Macula at the center of the field; color fundus photograph
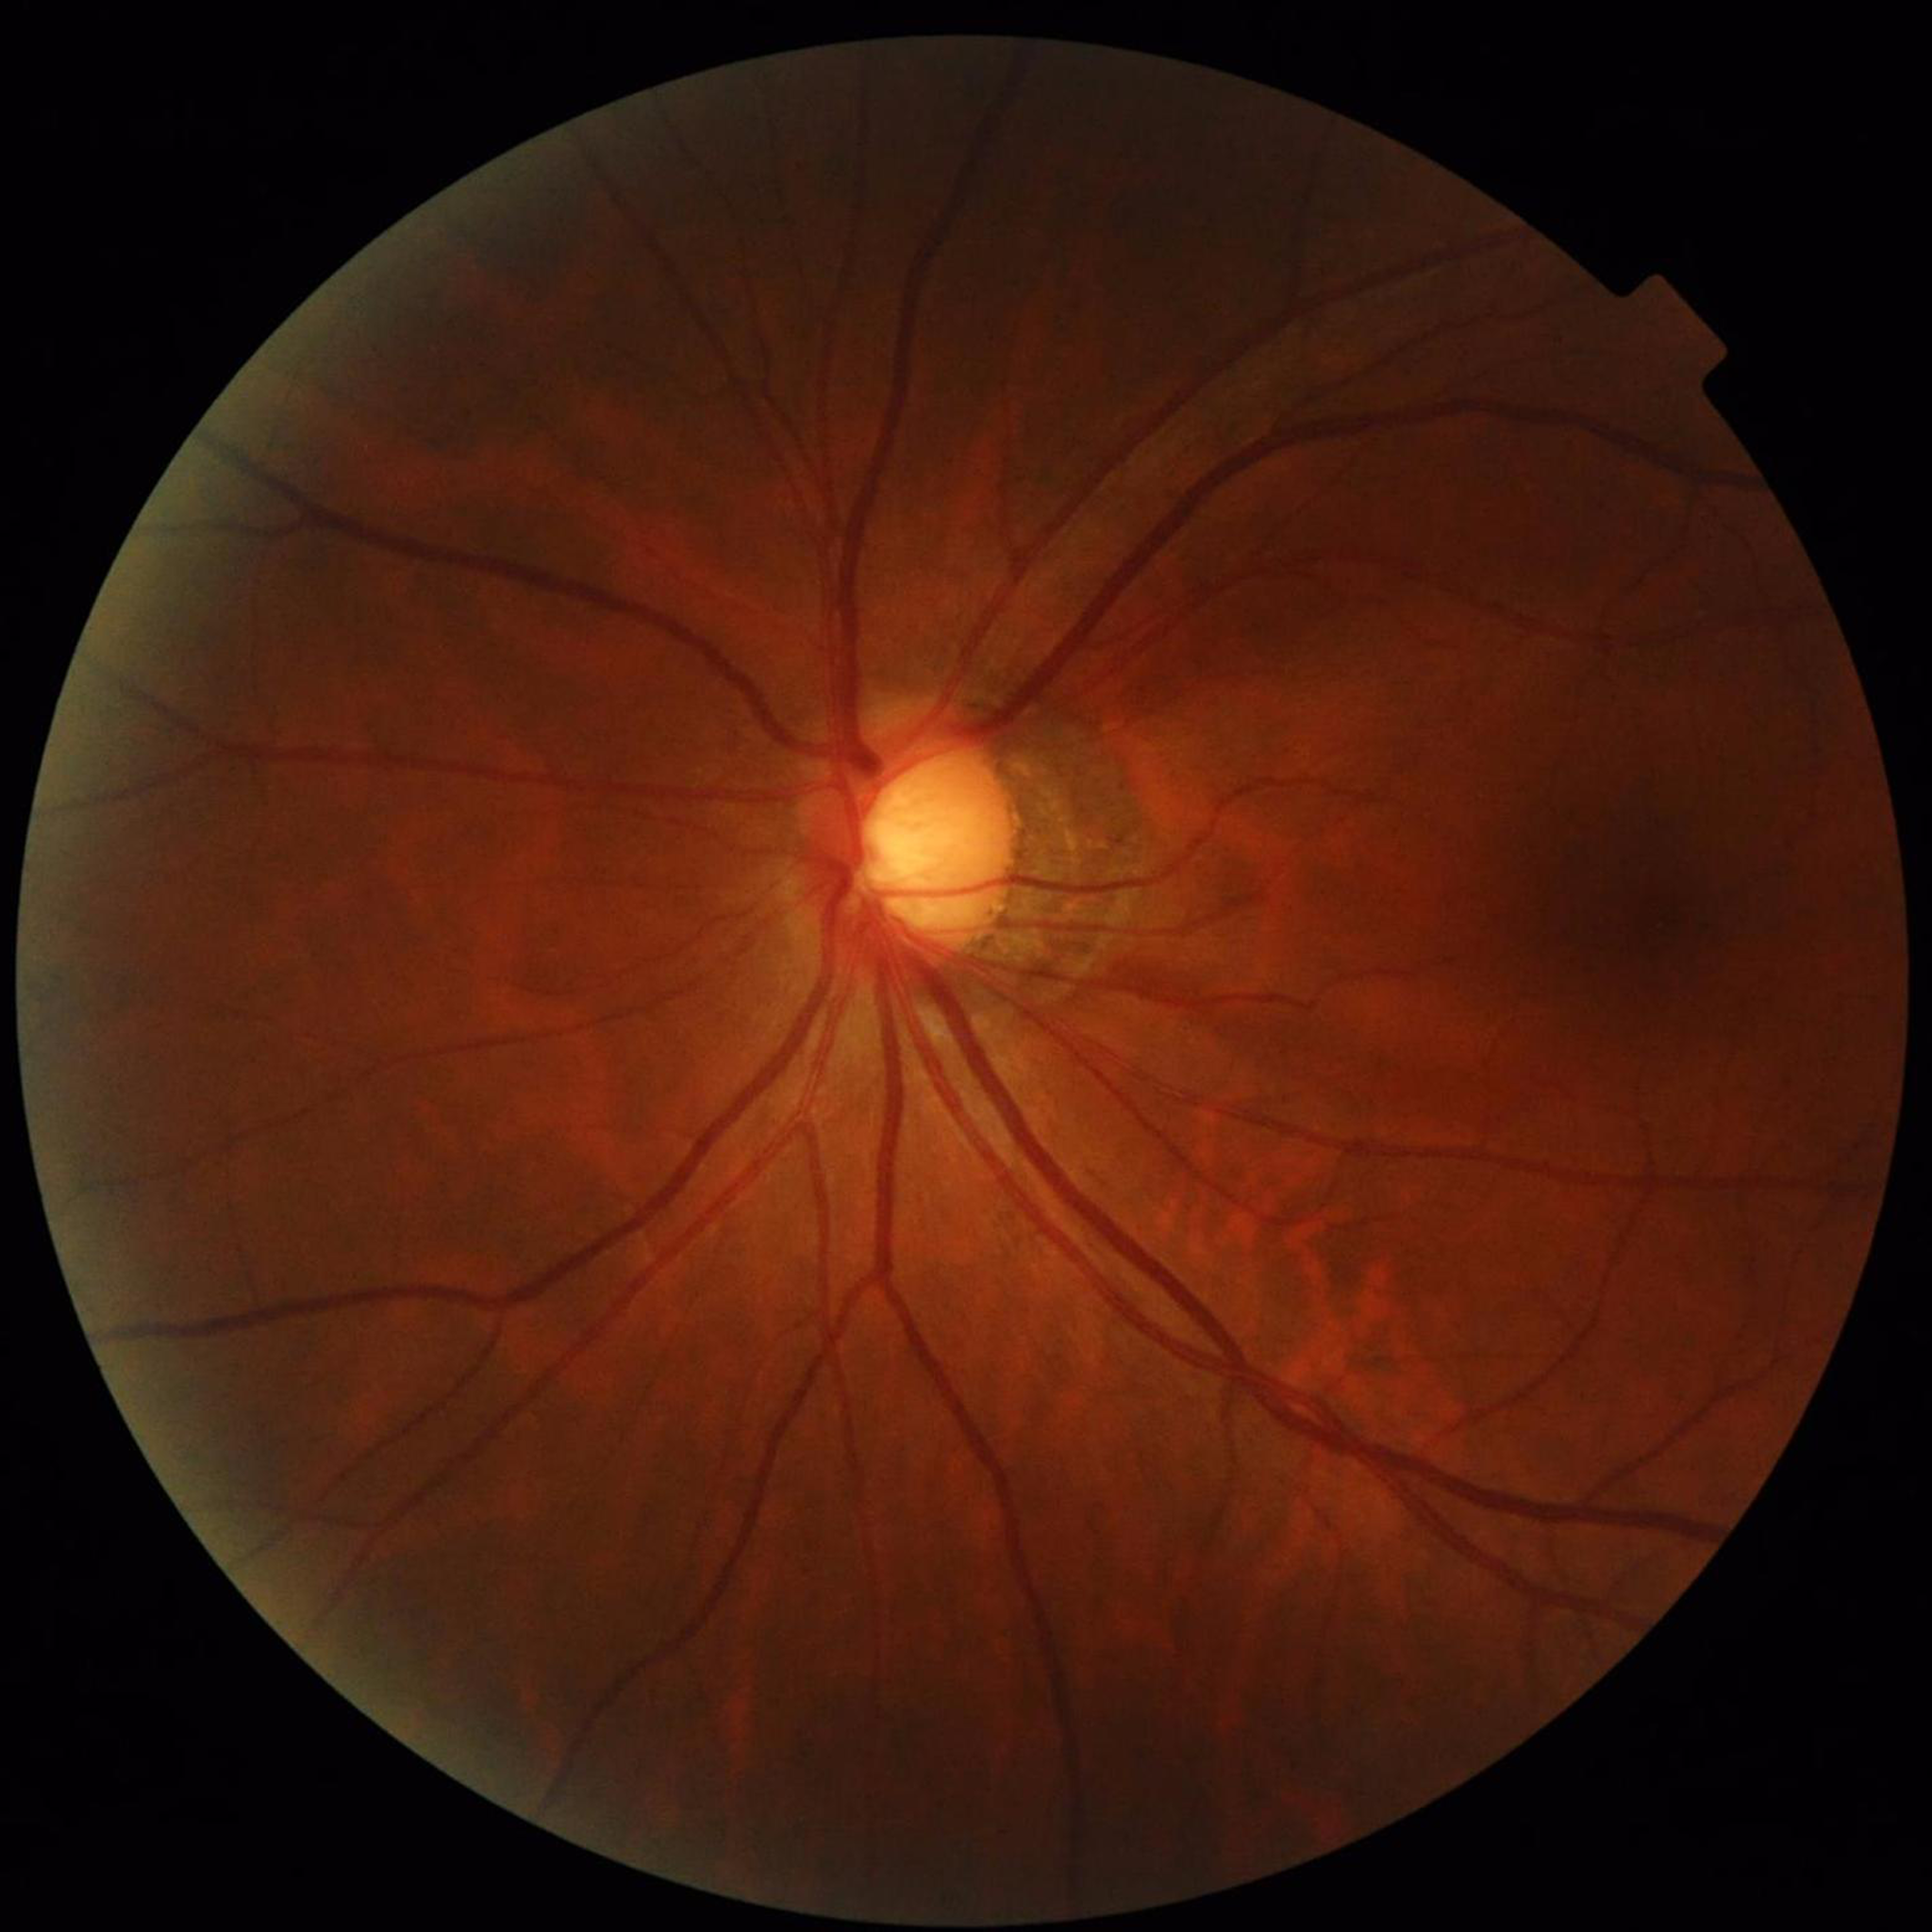

Disease: glaucoma.